Acquired on the Phoenix ICON; infant wide-field retinal image:
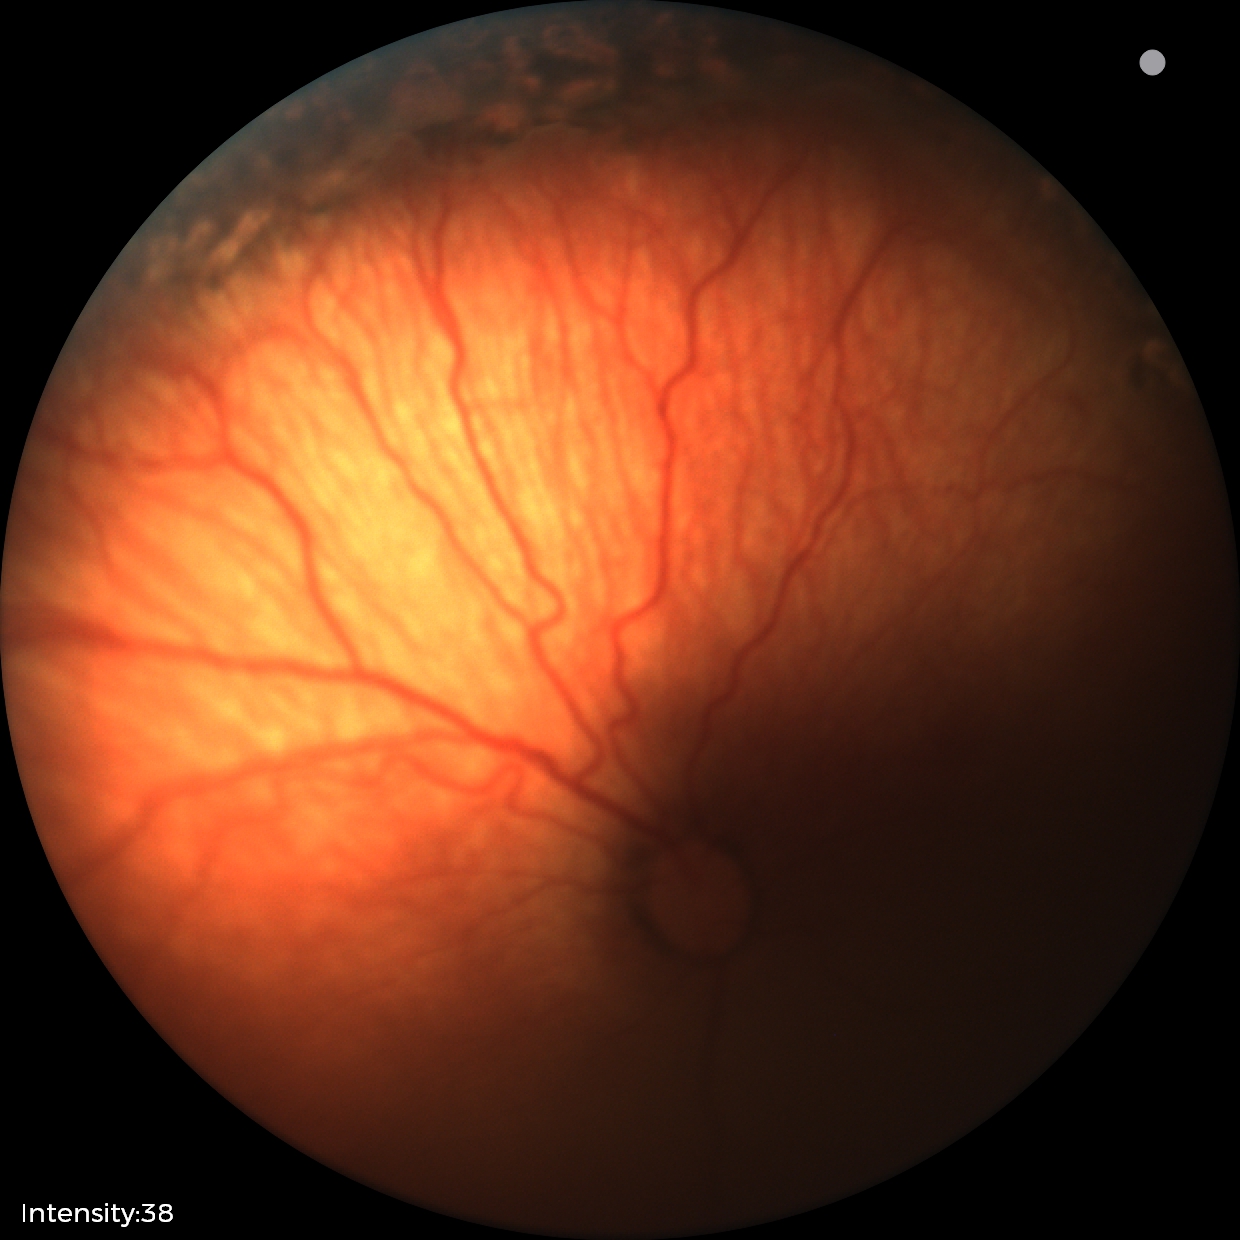
Screening diagnosis: status post retinopathy of prematurity (ROP) | no plus disease — posterior pole vessels without abnormal dilation or tortuosity.